Phoenix ICON, 100° FOV; wide-field fundus photograph from neonatal ROP screening
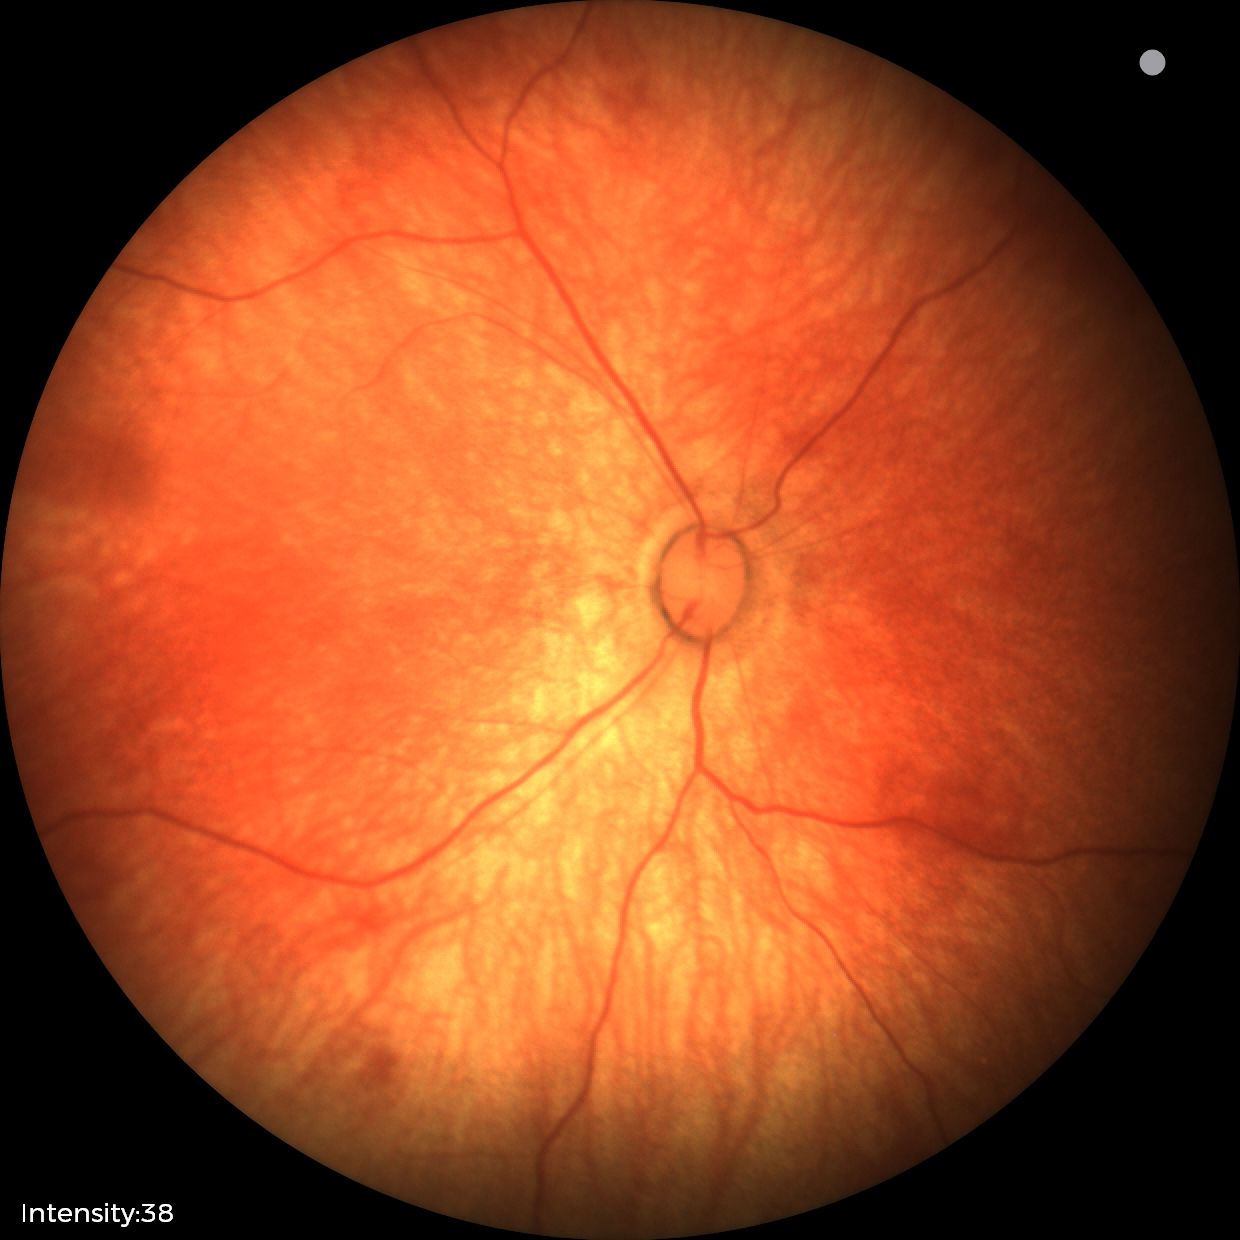

Assessment = physiological appearance.